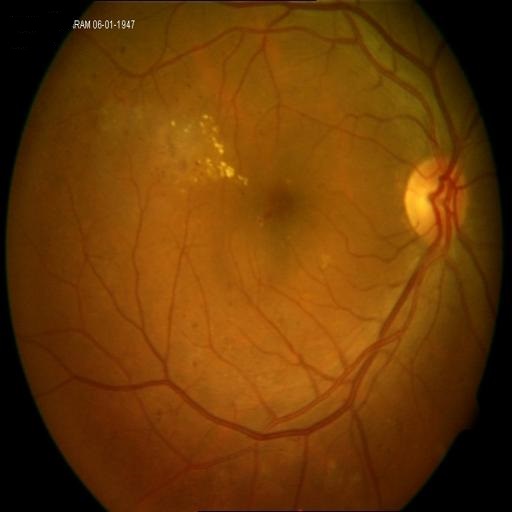
Diagnosis (2): exudation | hemorrhagic retinopathy.